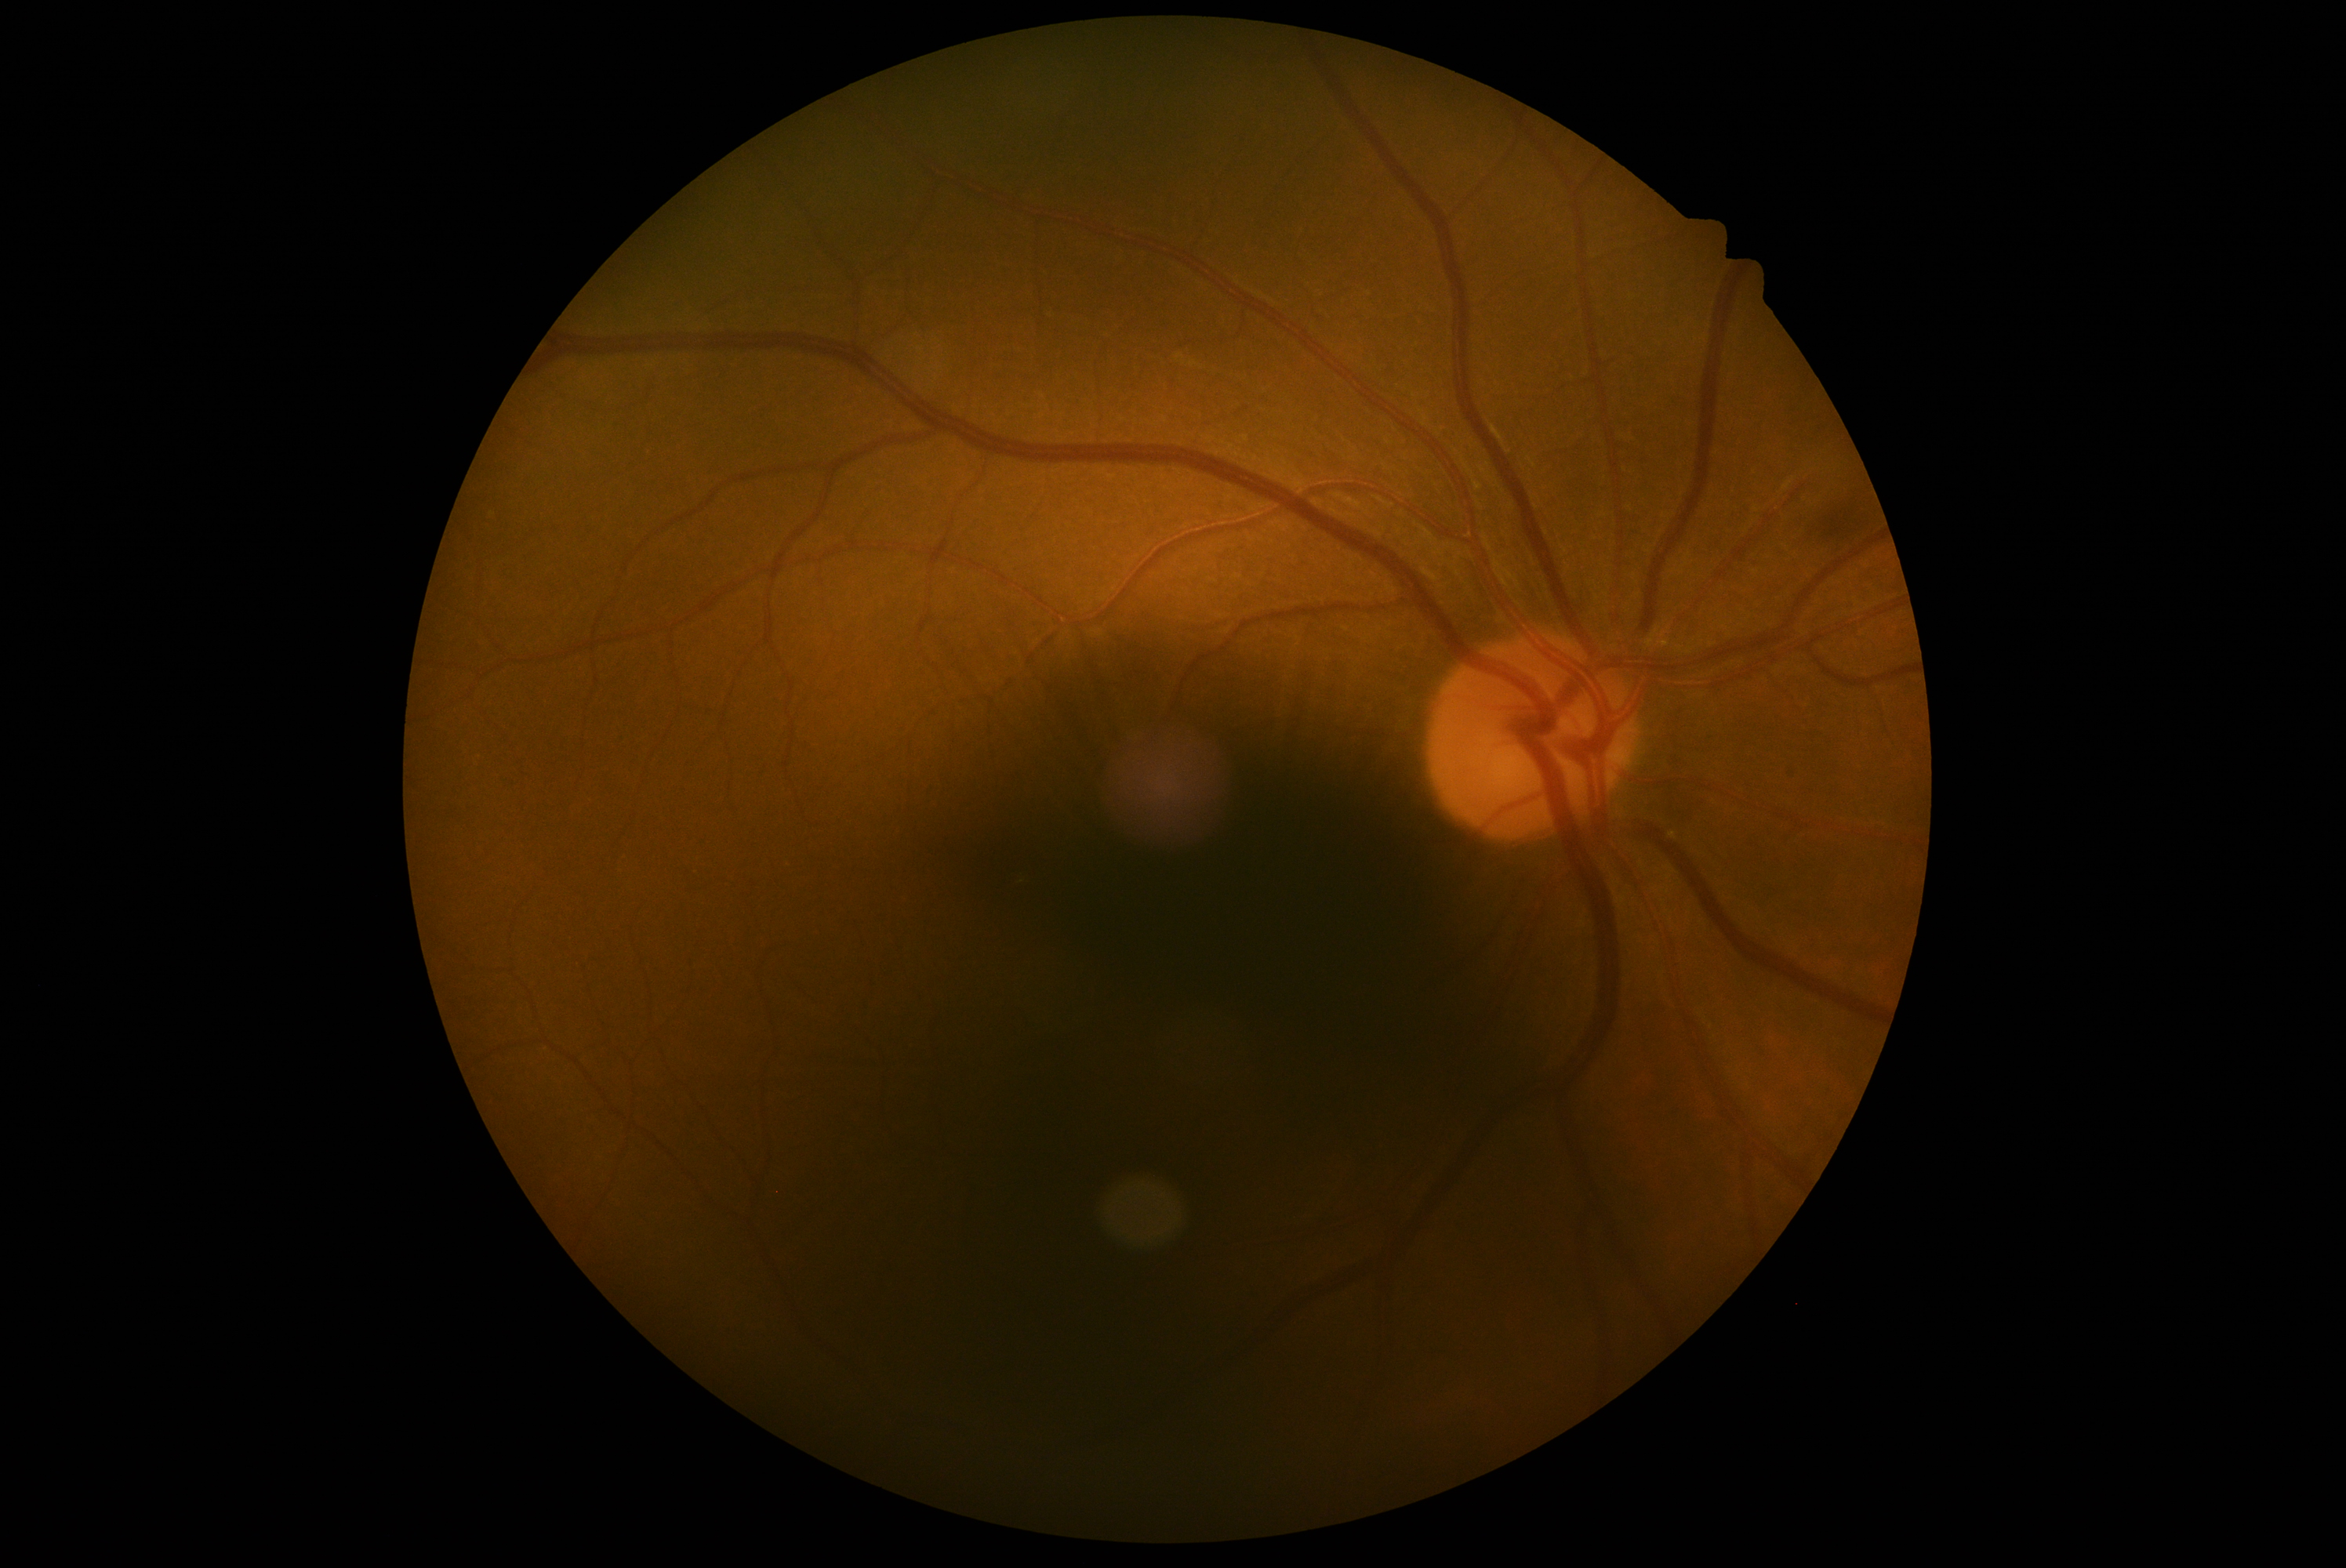
DR=moderate NPDR (grade 2); DR class=non-proliferative diabetic retinopathy.